2352 by 1568 pixels; FOV: 45 degrees; color fundus photograph: 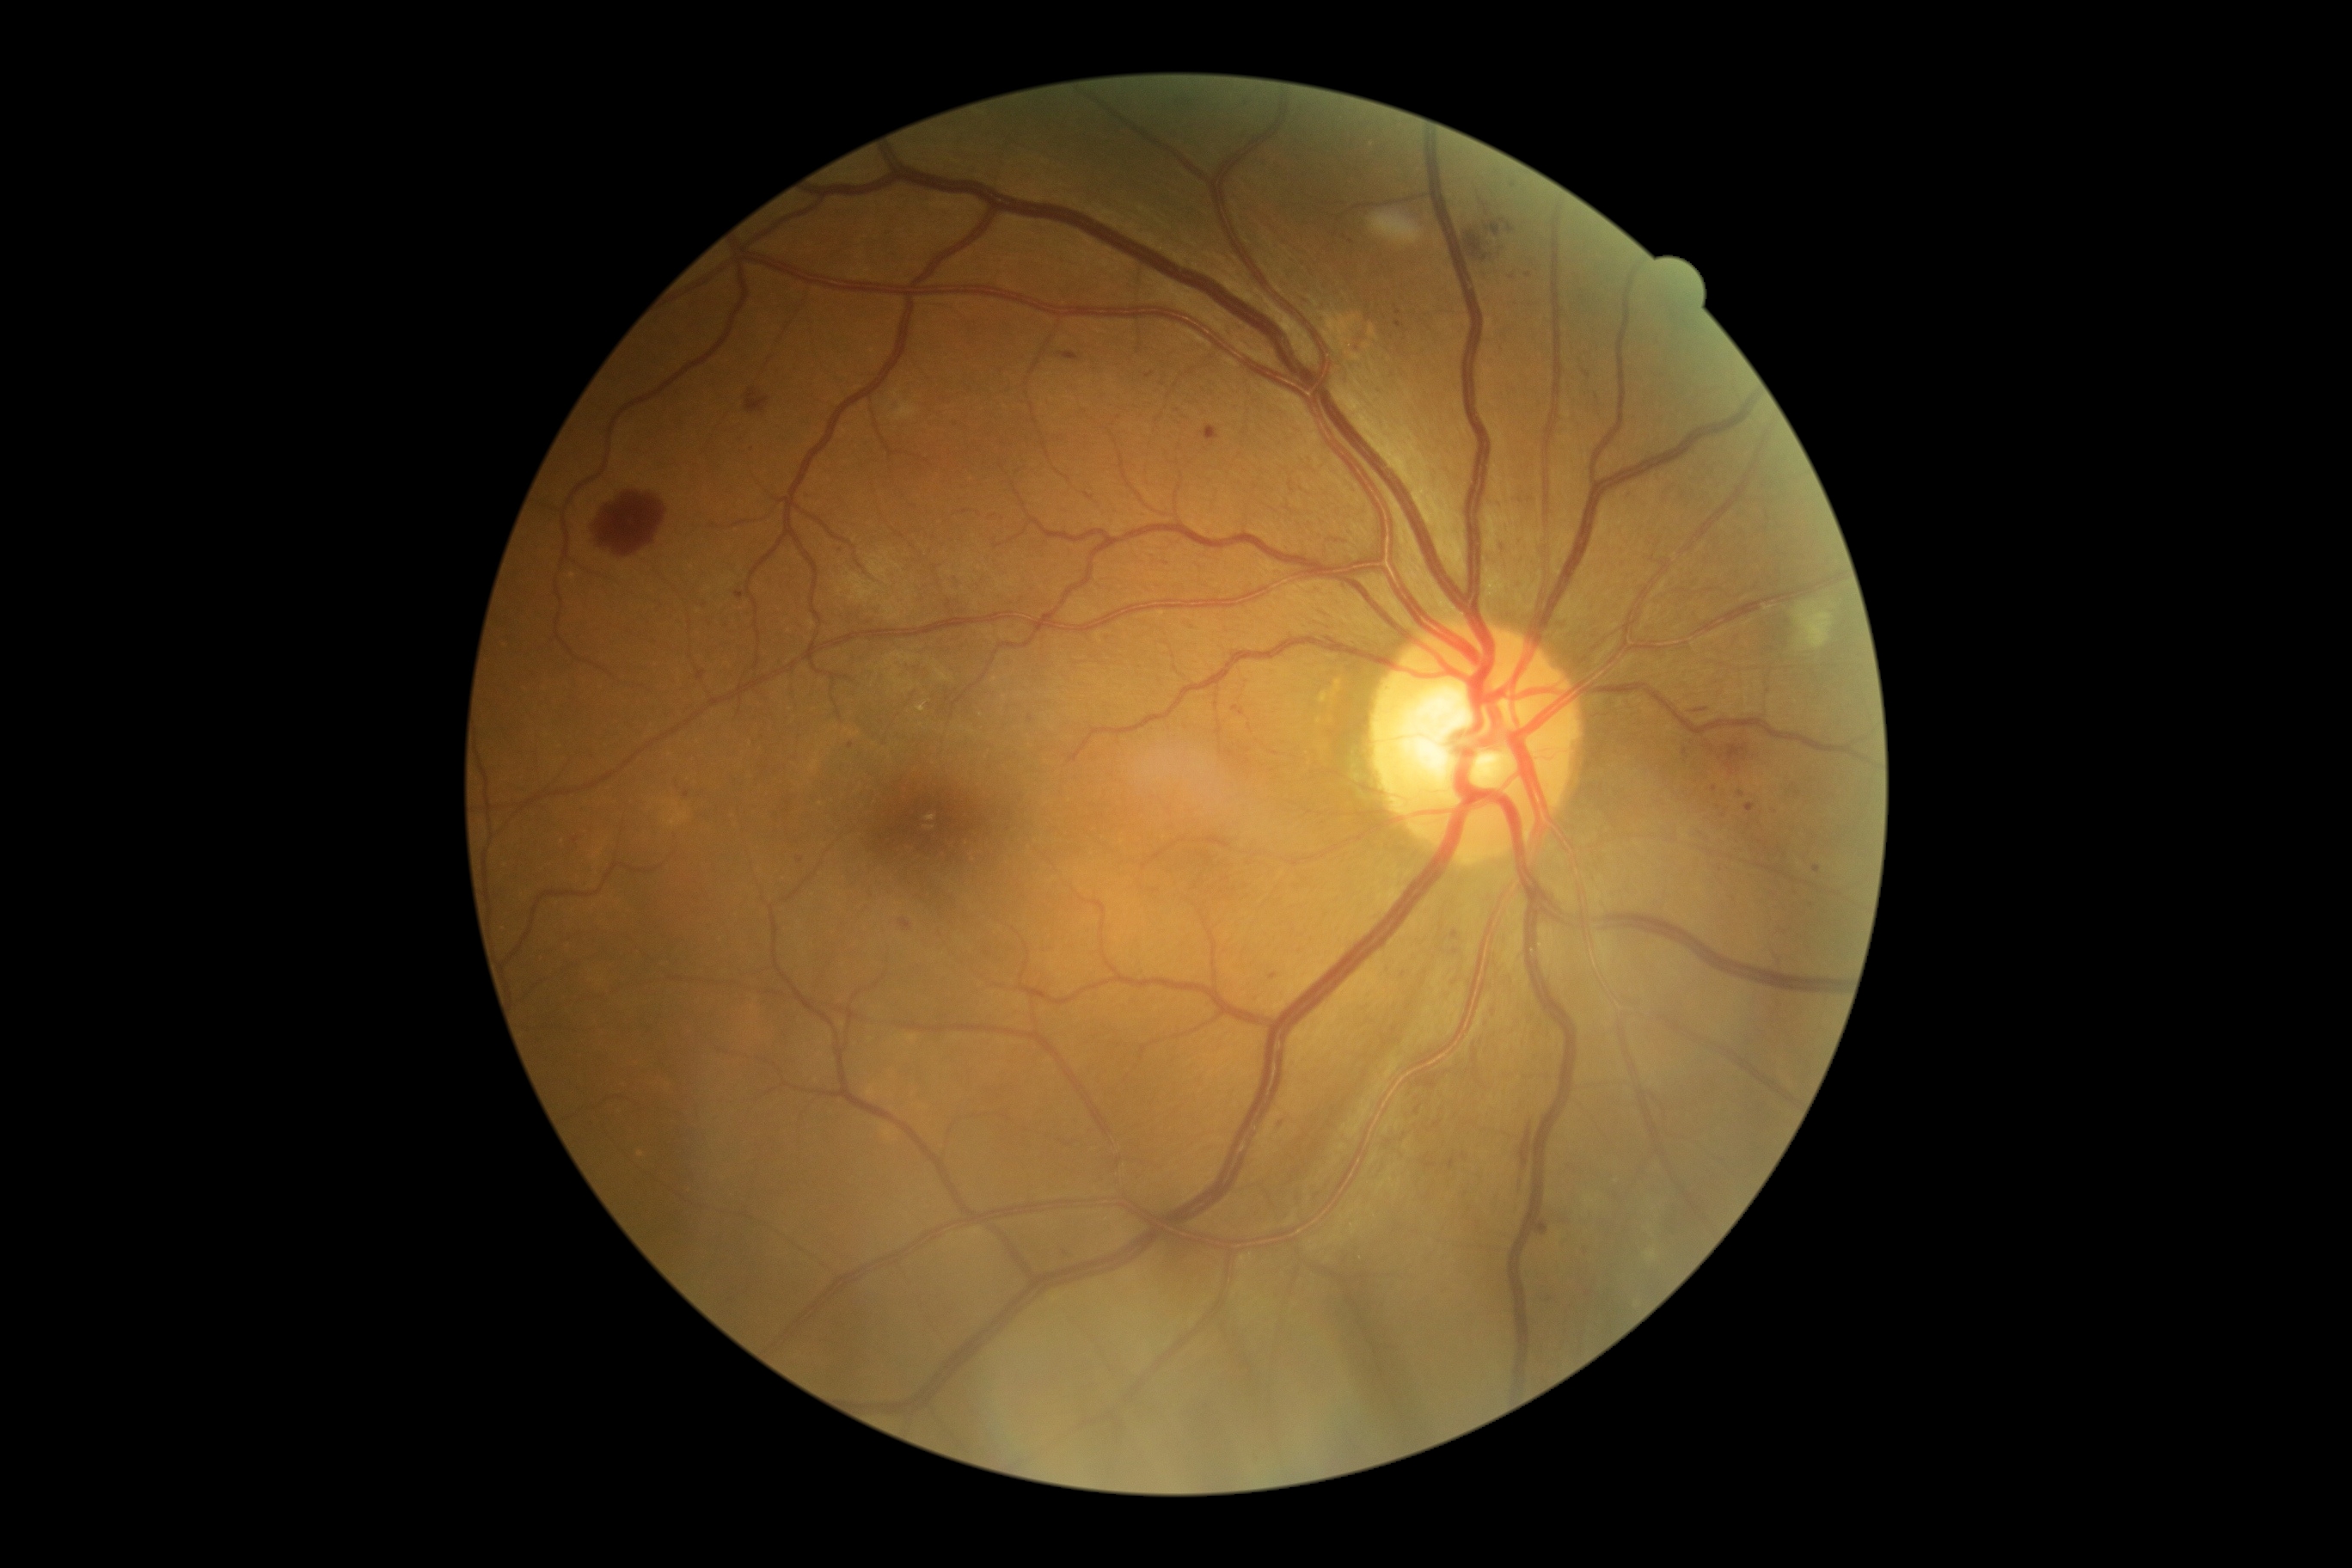

DR: moderate NPDR (grade 2).